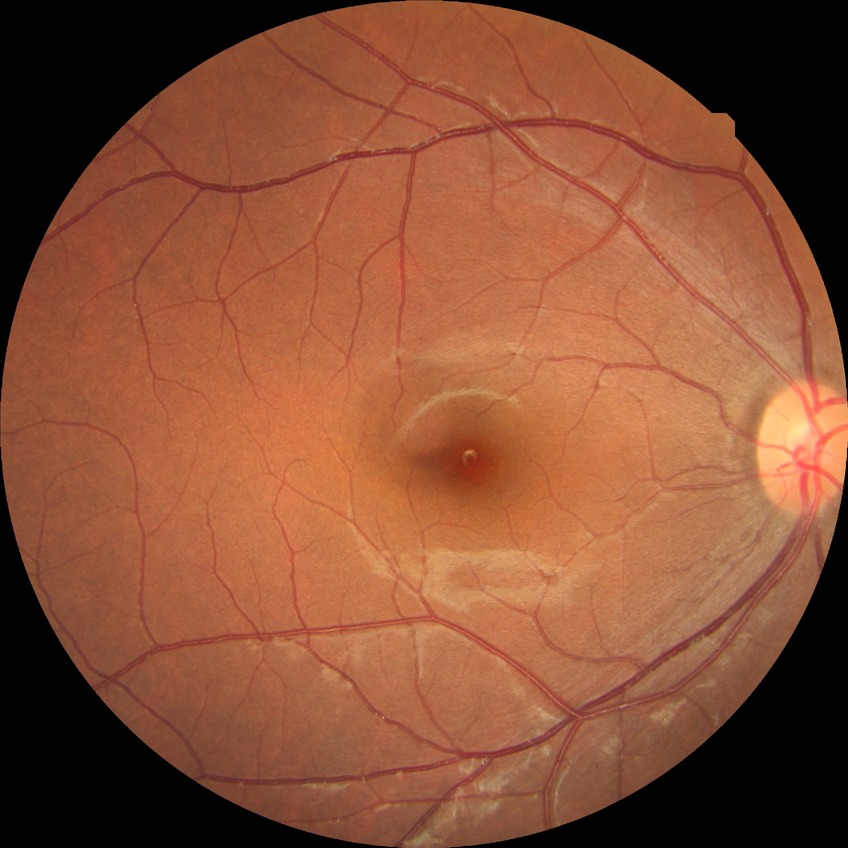

Diabetic retinopathy (DR) is no diabetic retinopathy (NDR).